Graded on the modified Davis scale:
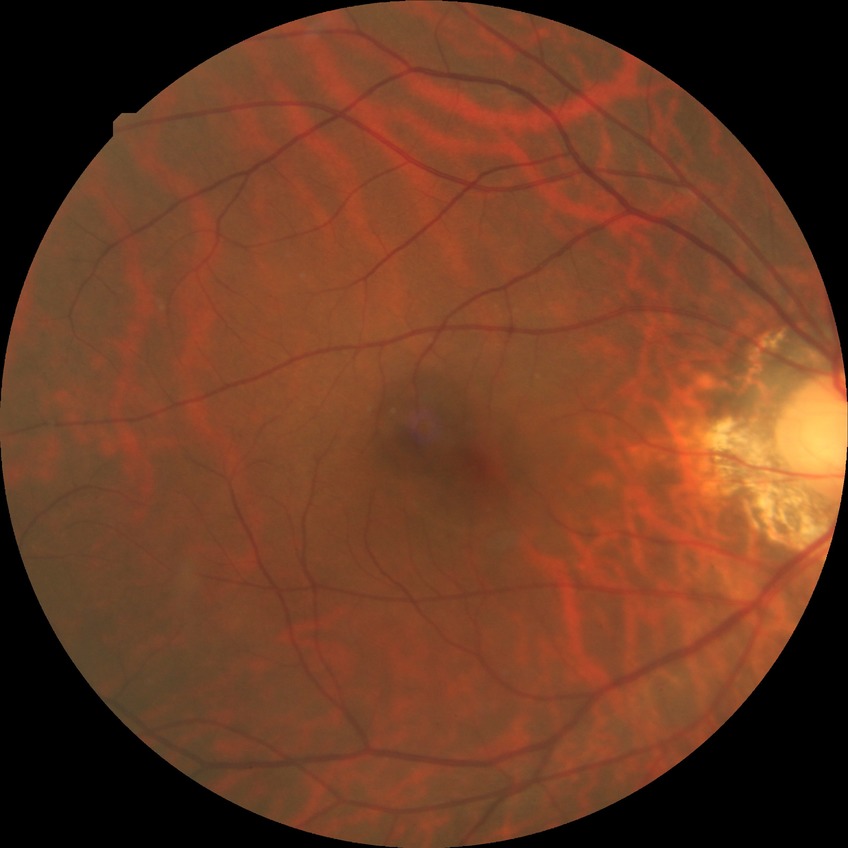

Davis DR grade: NDR.